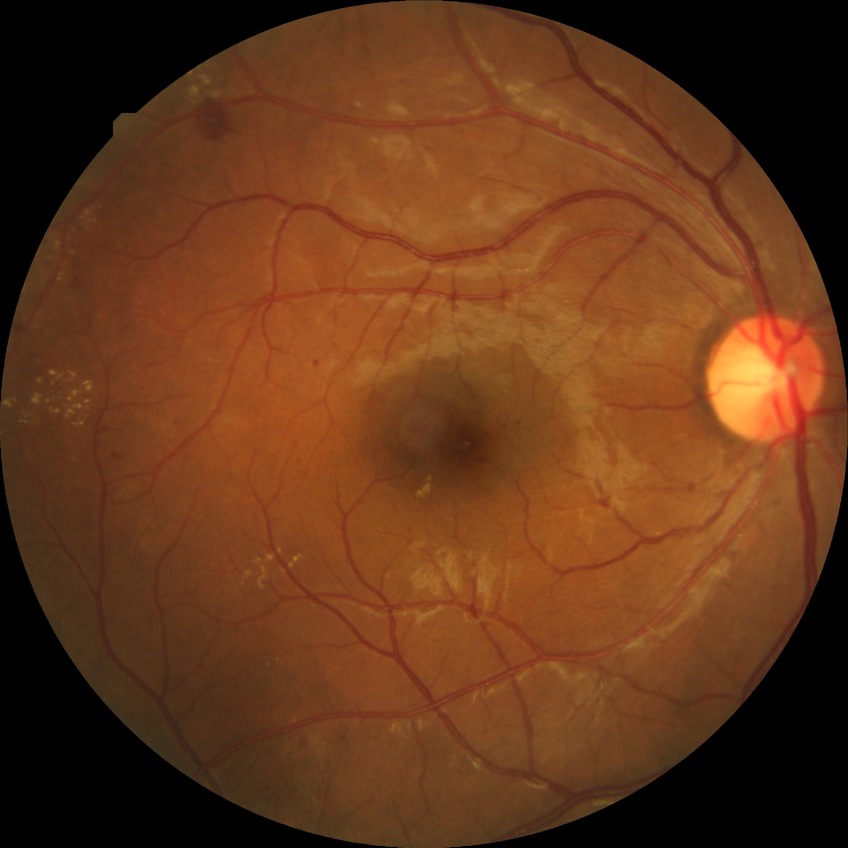

Diabetic retinopathy (DR): SDR (simple diabetic retinopathy).